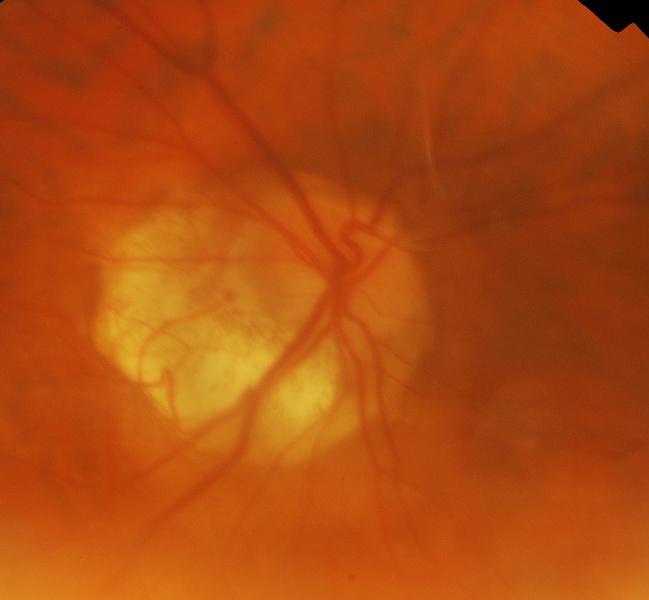

Demonstrates glaucomatous findings.